Pupil-dilated — 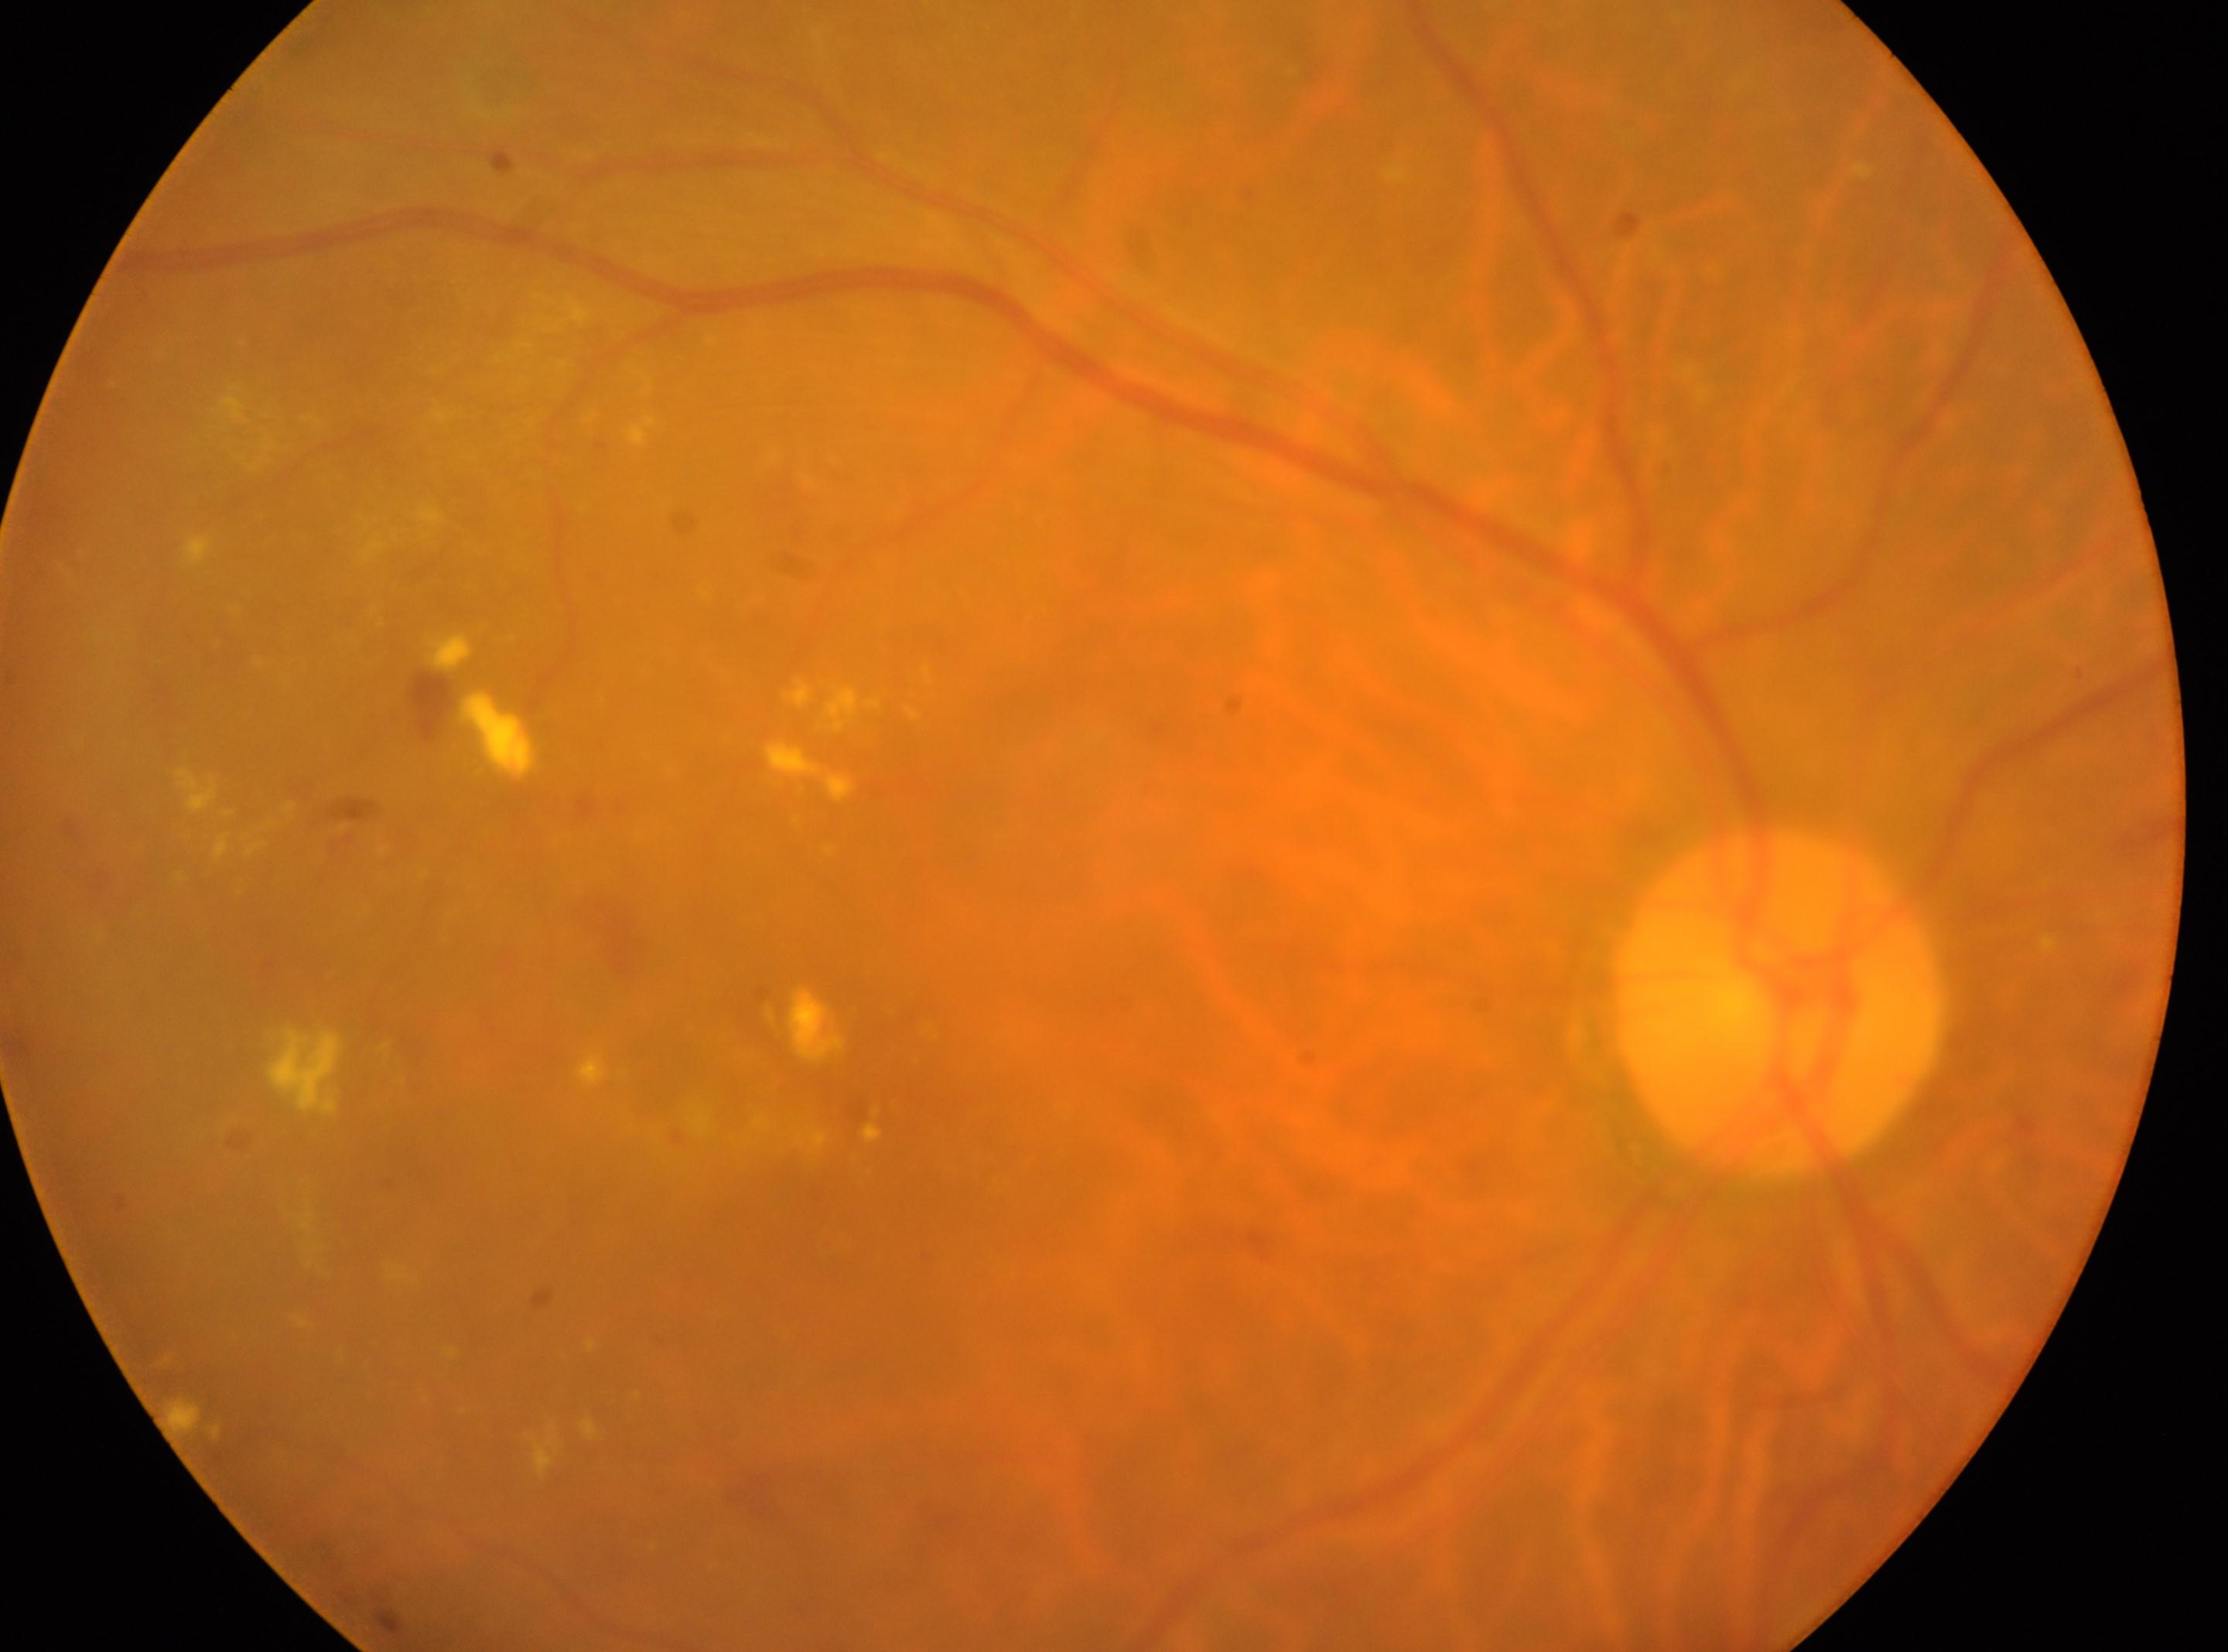

fovea center = (x: 891, y: 1078) | eye = OD | DR = DR with laser photocoagulation scars, reclassified as moderate non-proliferative diabetic retinopathy (grade 2) | optic disc center = (x: 1775, y: 1002).